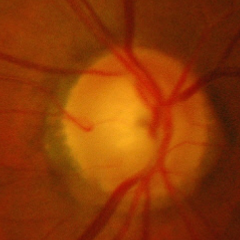 Advanced glaucomatous optic neuropathy.